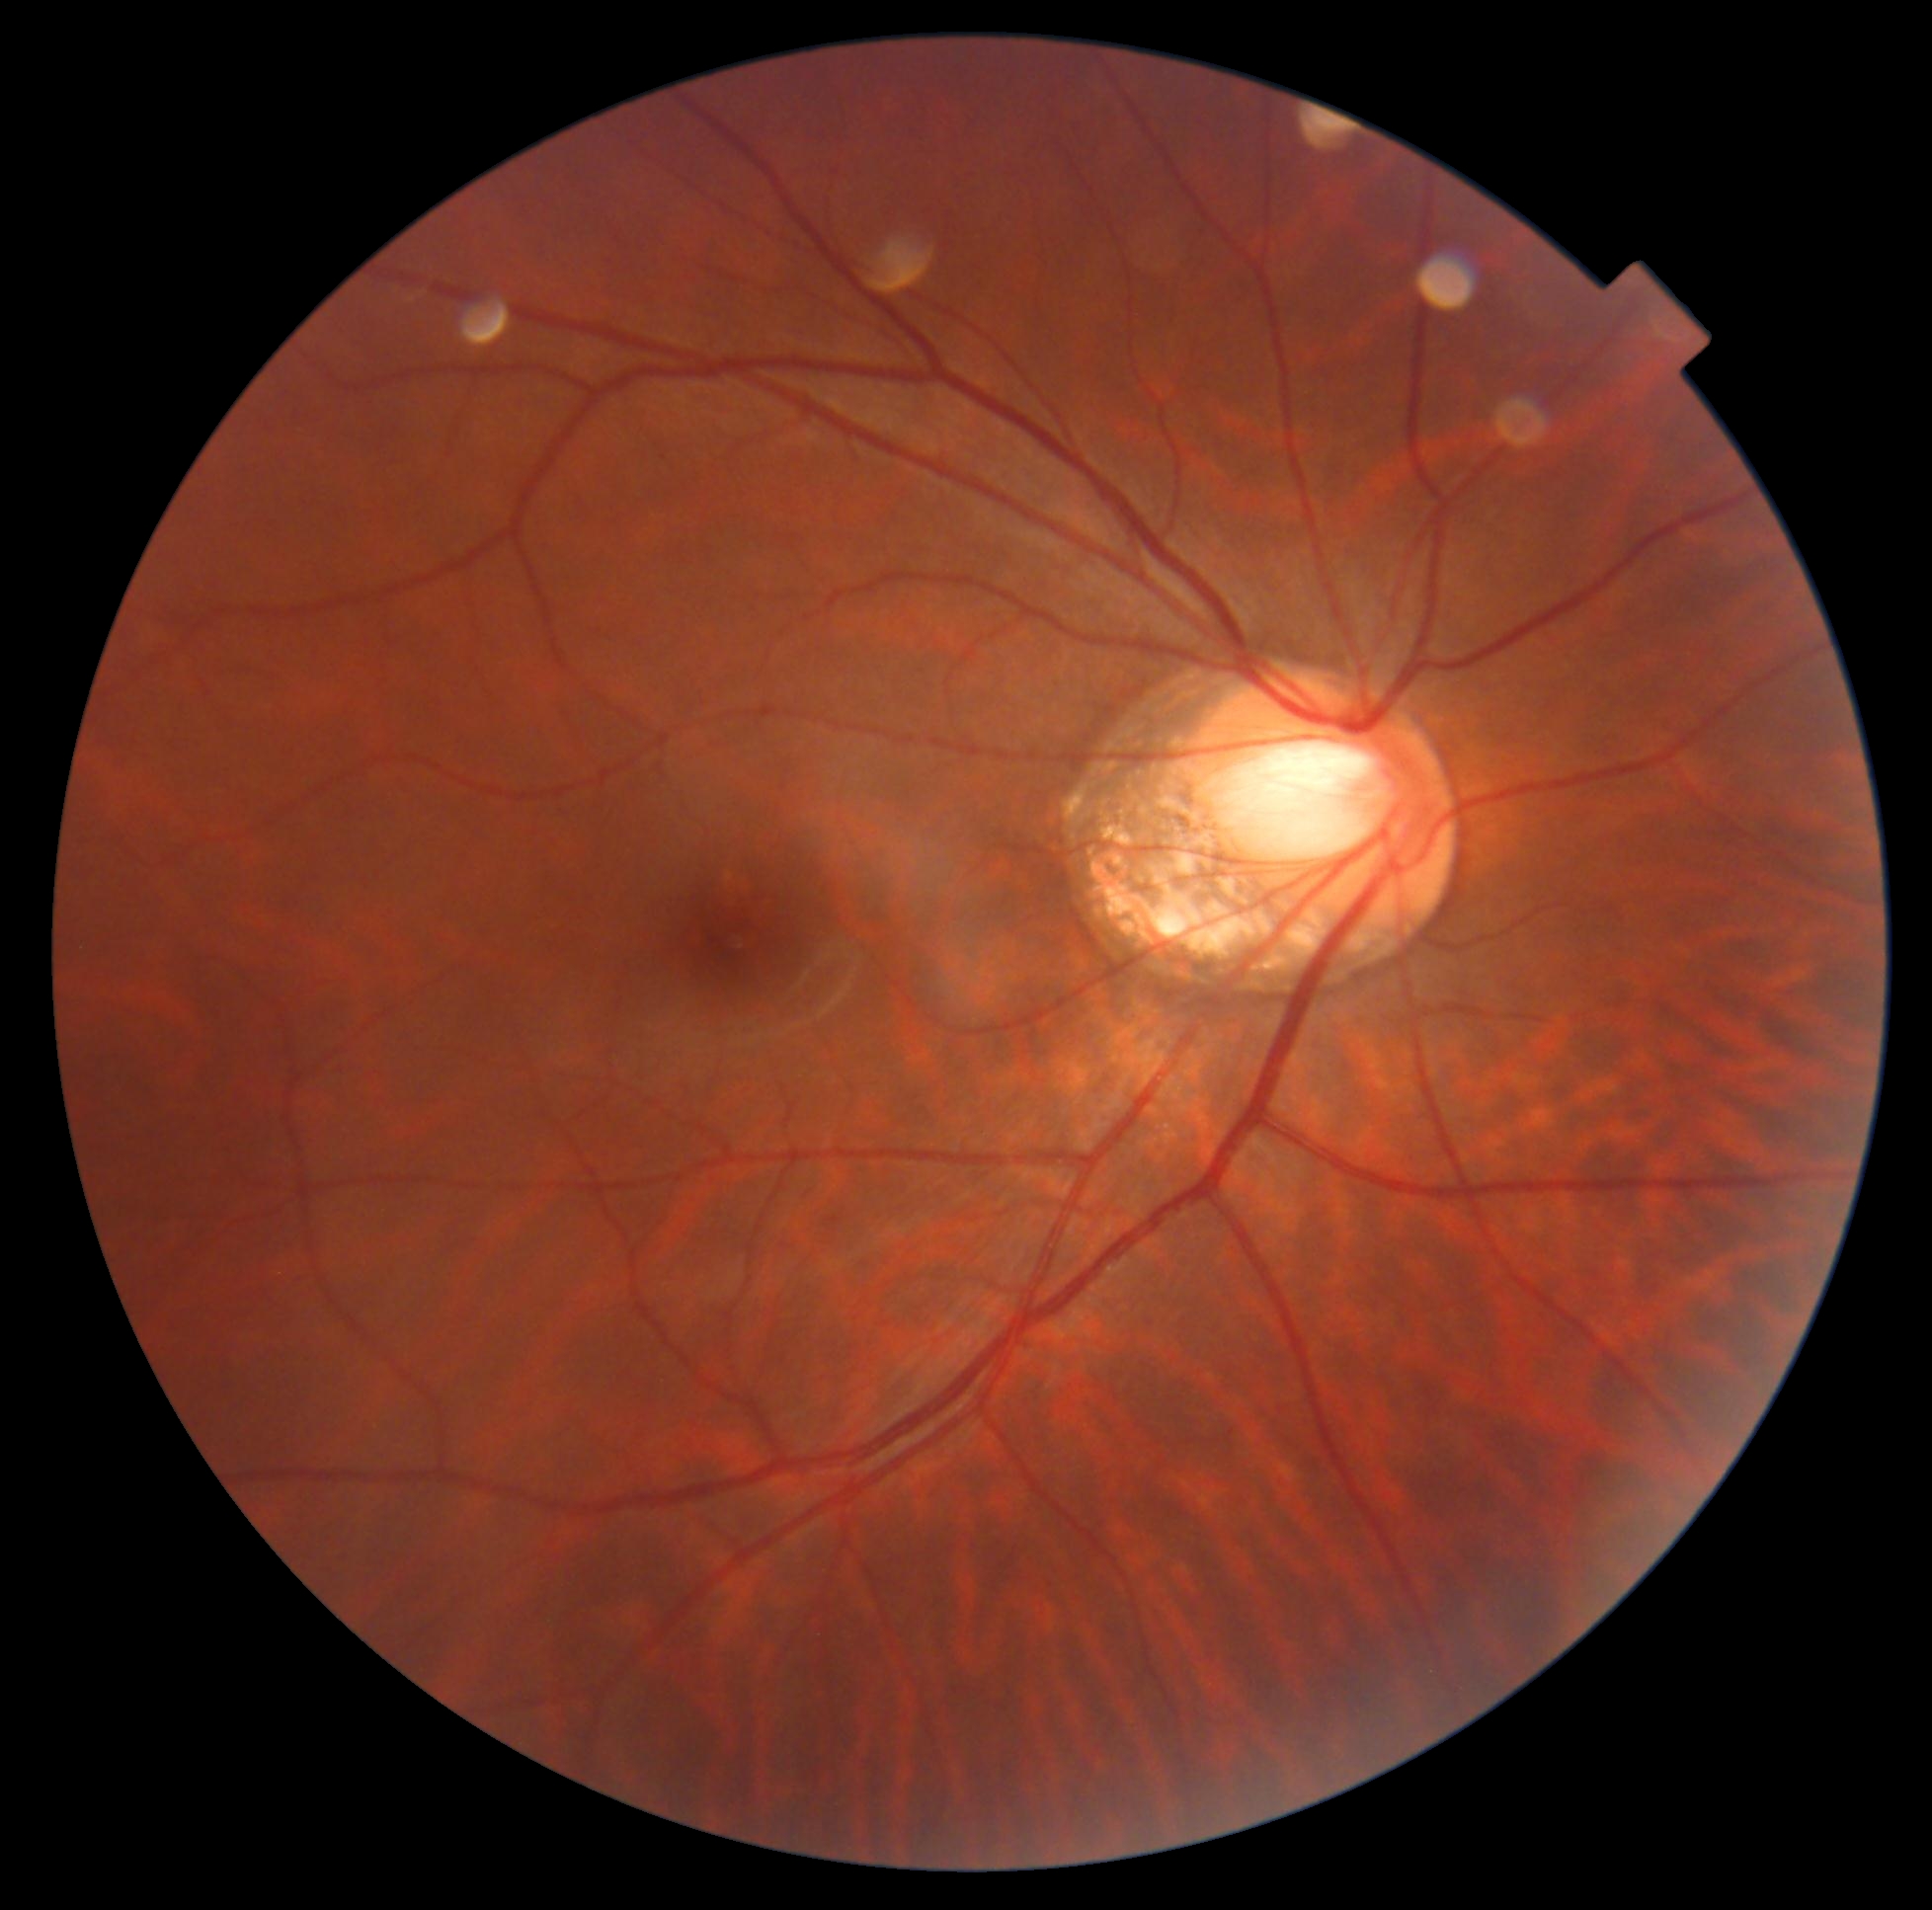
Retinopathy grade: 0.